2352 x 1568 pixels — 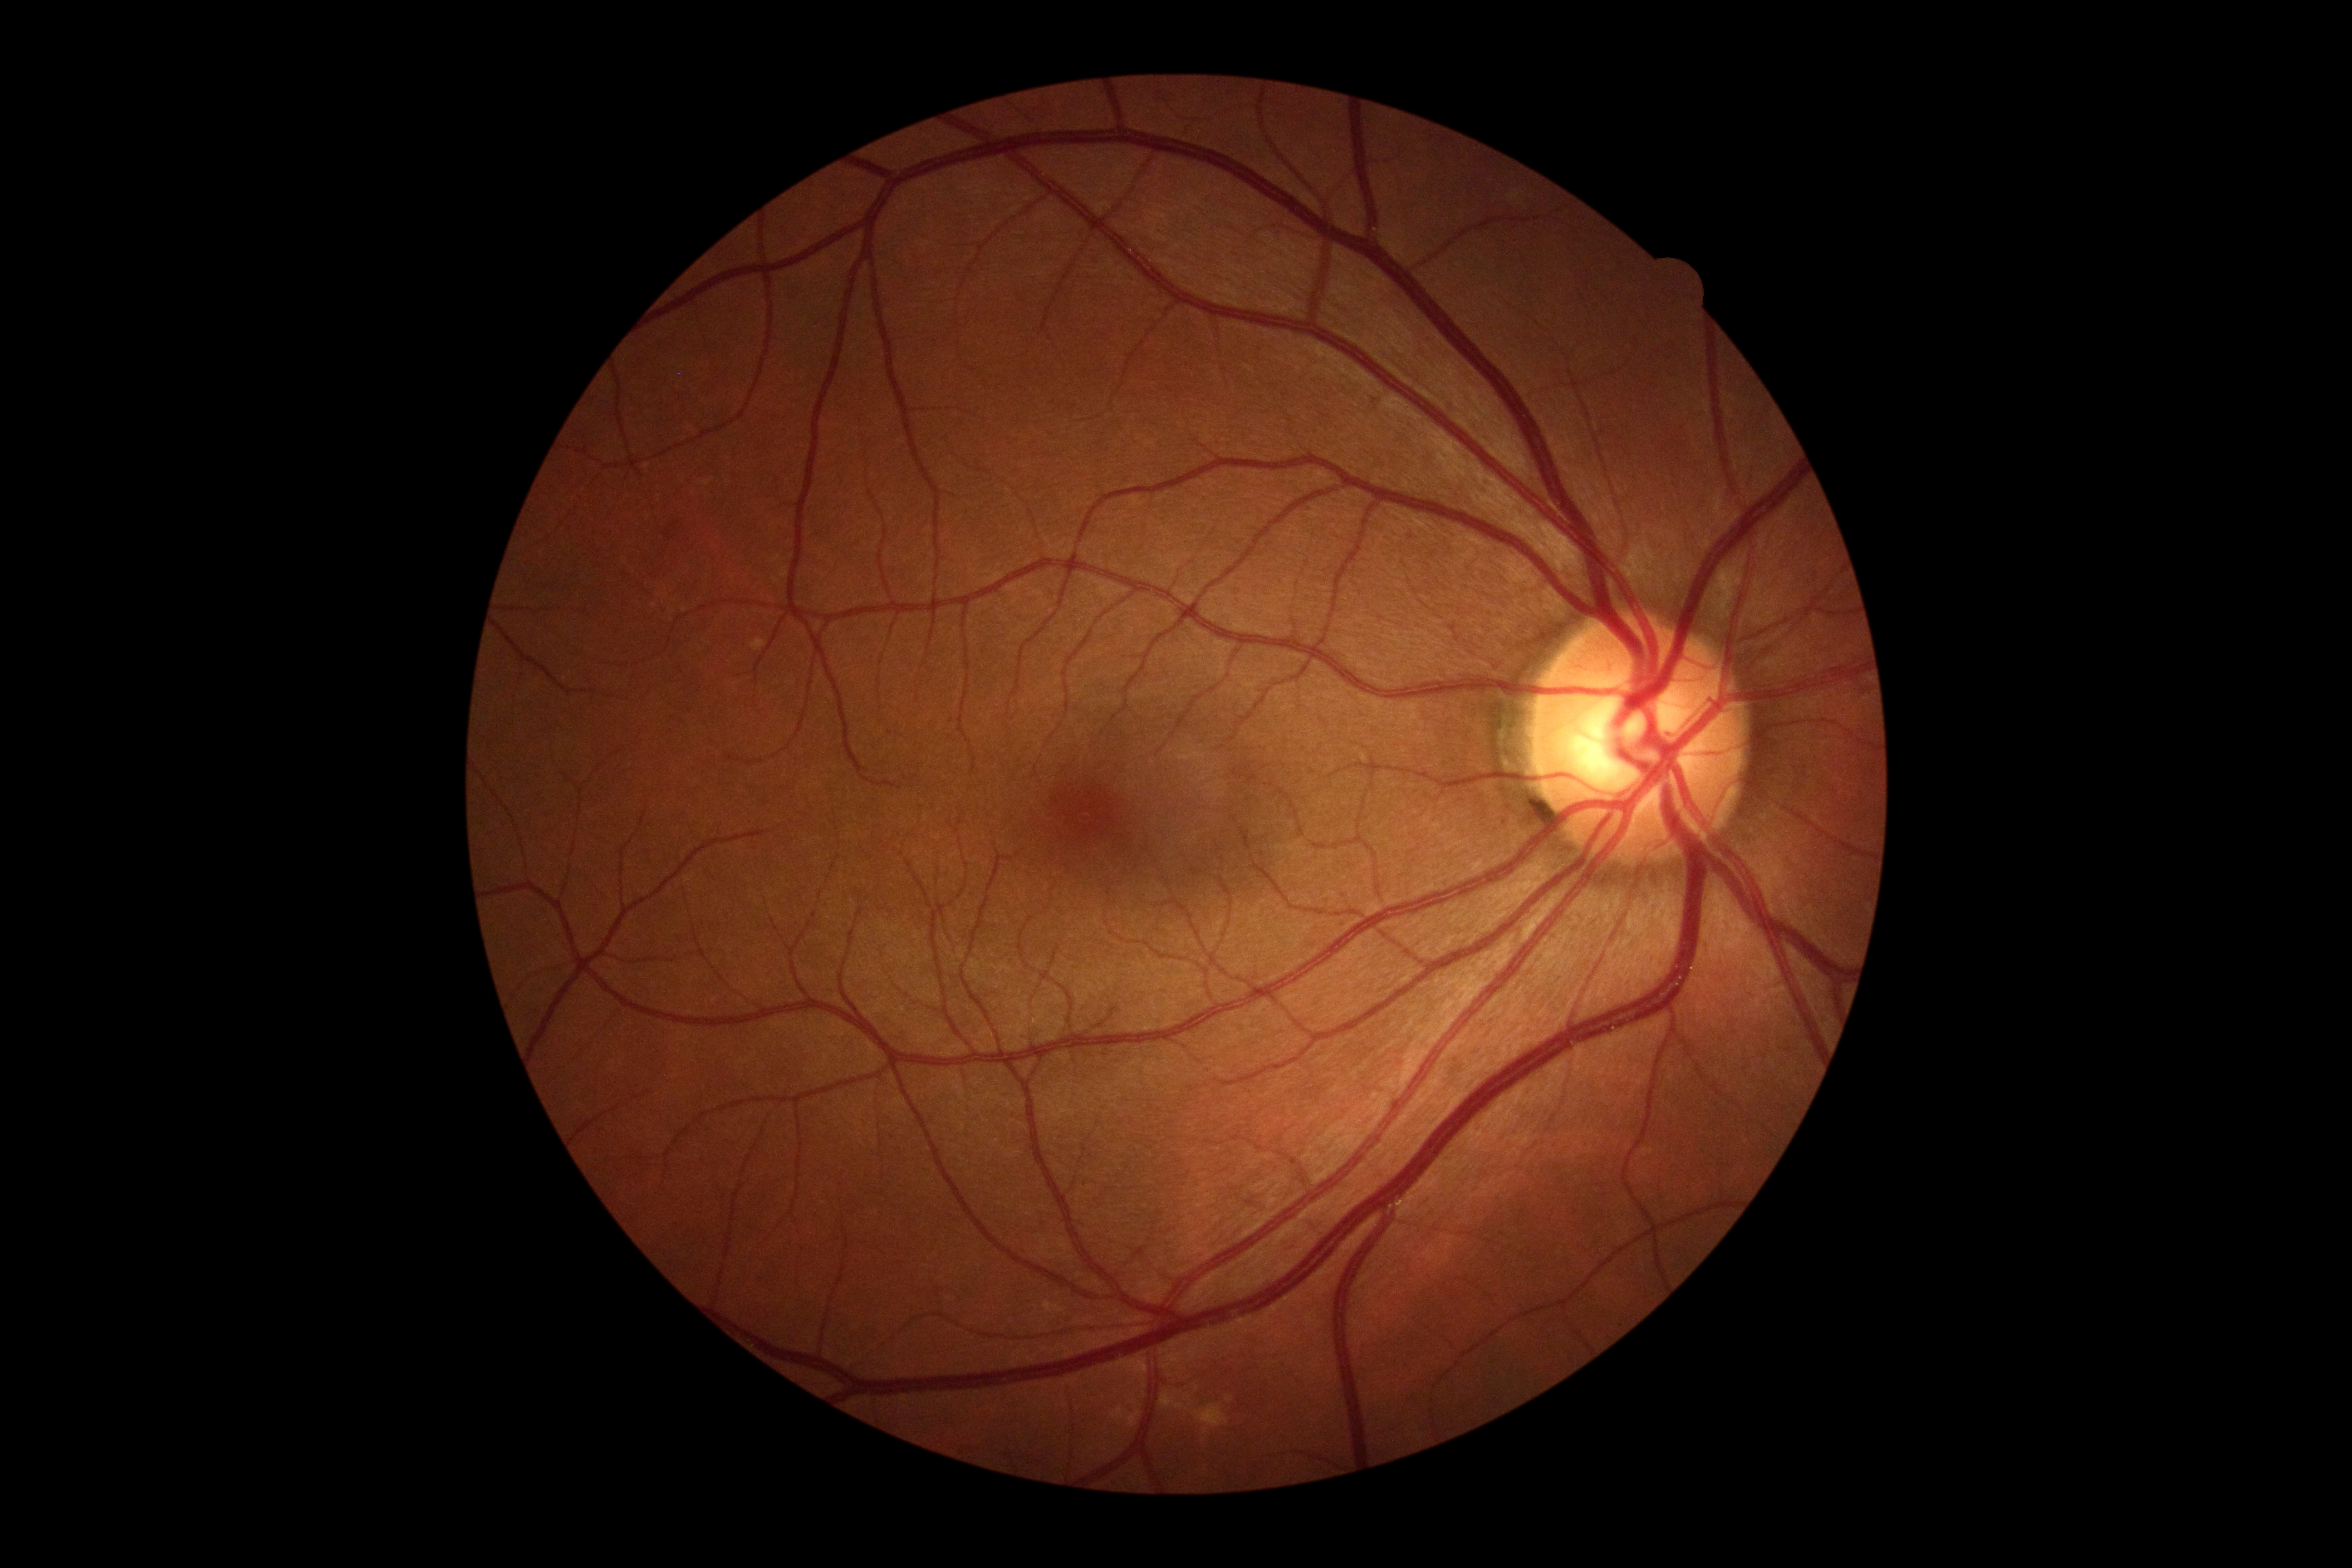

Diabetic retinopathy (DR) is no apparent retinopathy (grade 0).
No apparent diabetic retinopathy.